1240x1240. Wide-field fundus photograph of an infant. Phoenix ICON, 100° FOV
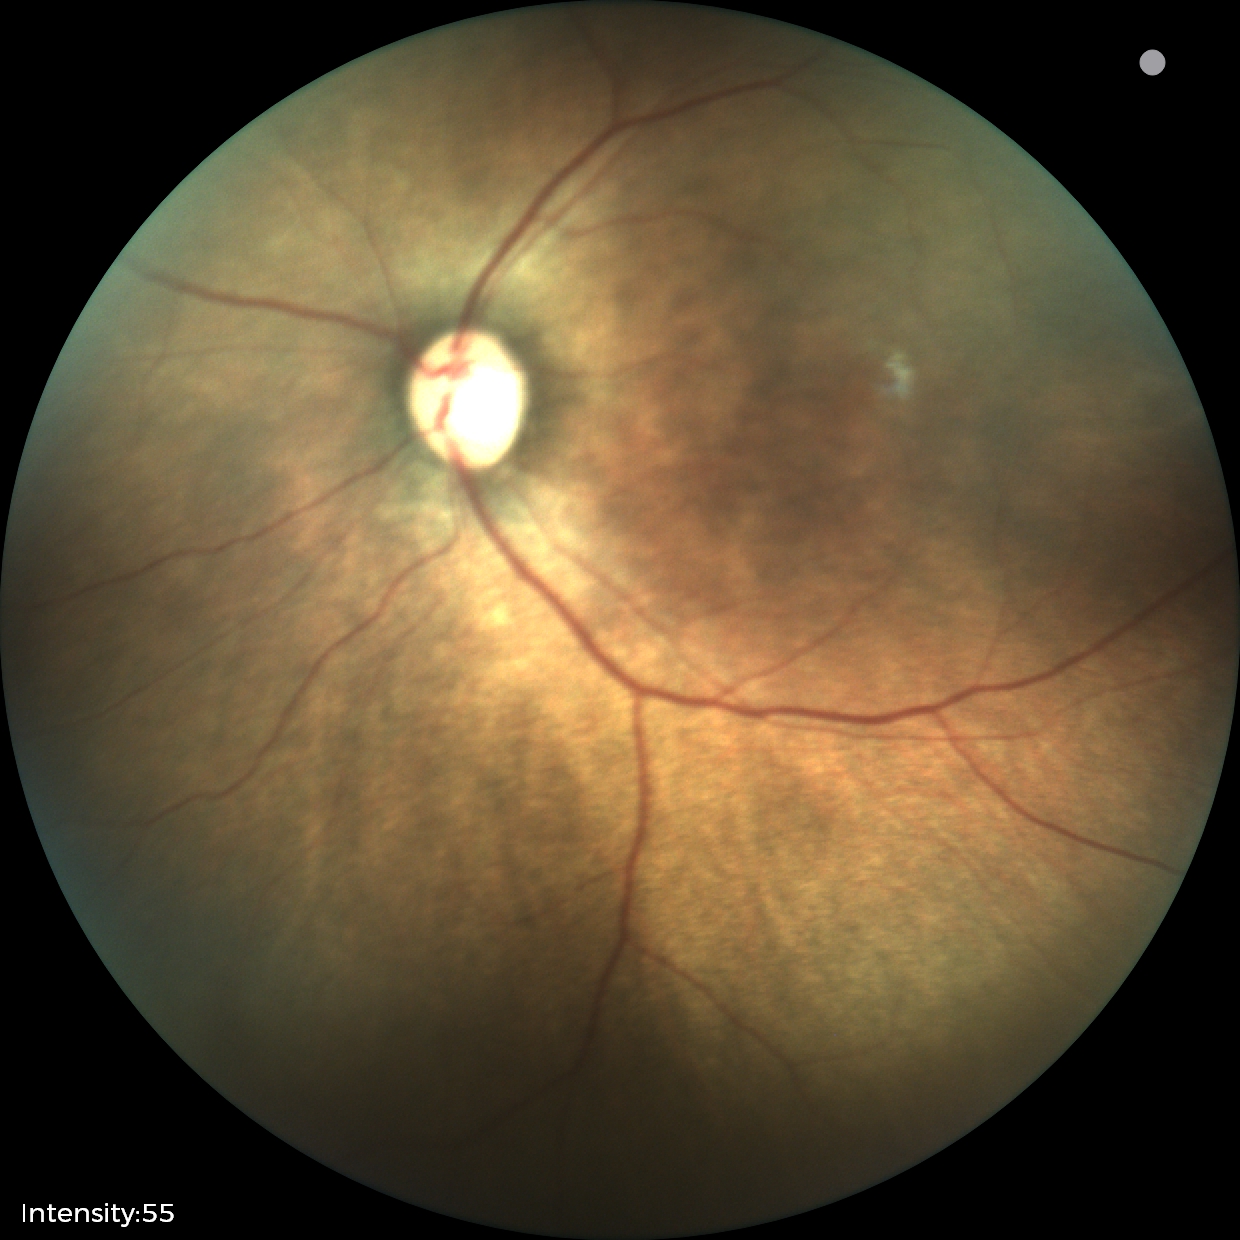

Screening examination consistent with status post retinopathy of prematurity.